2048x1536; fundus photo
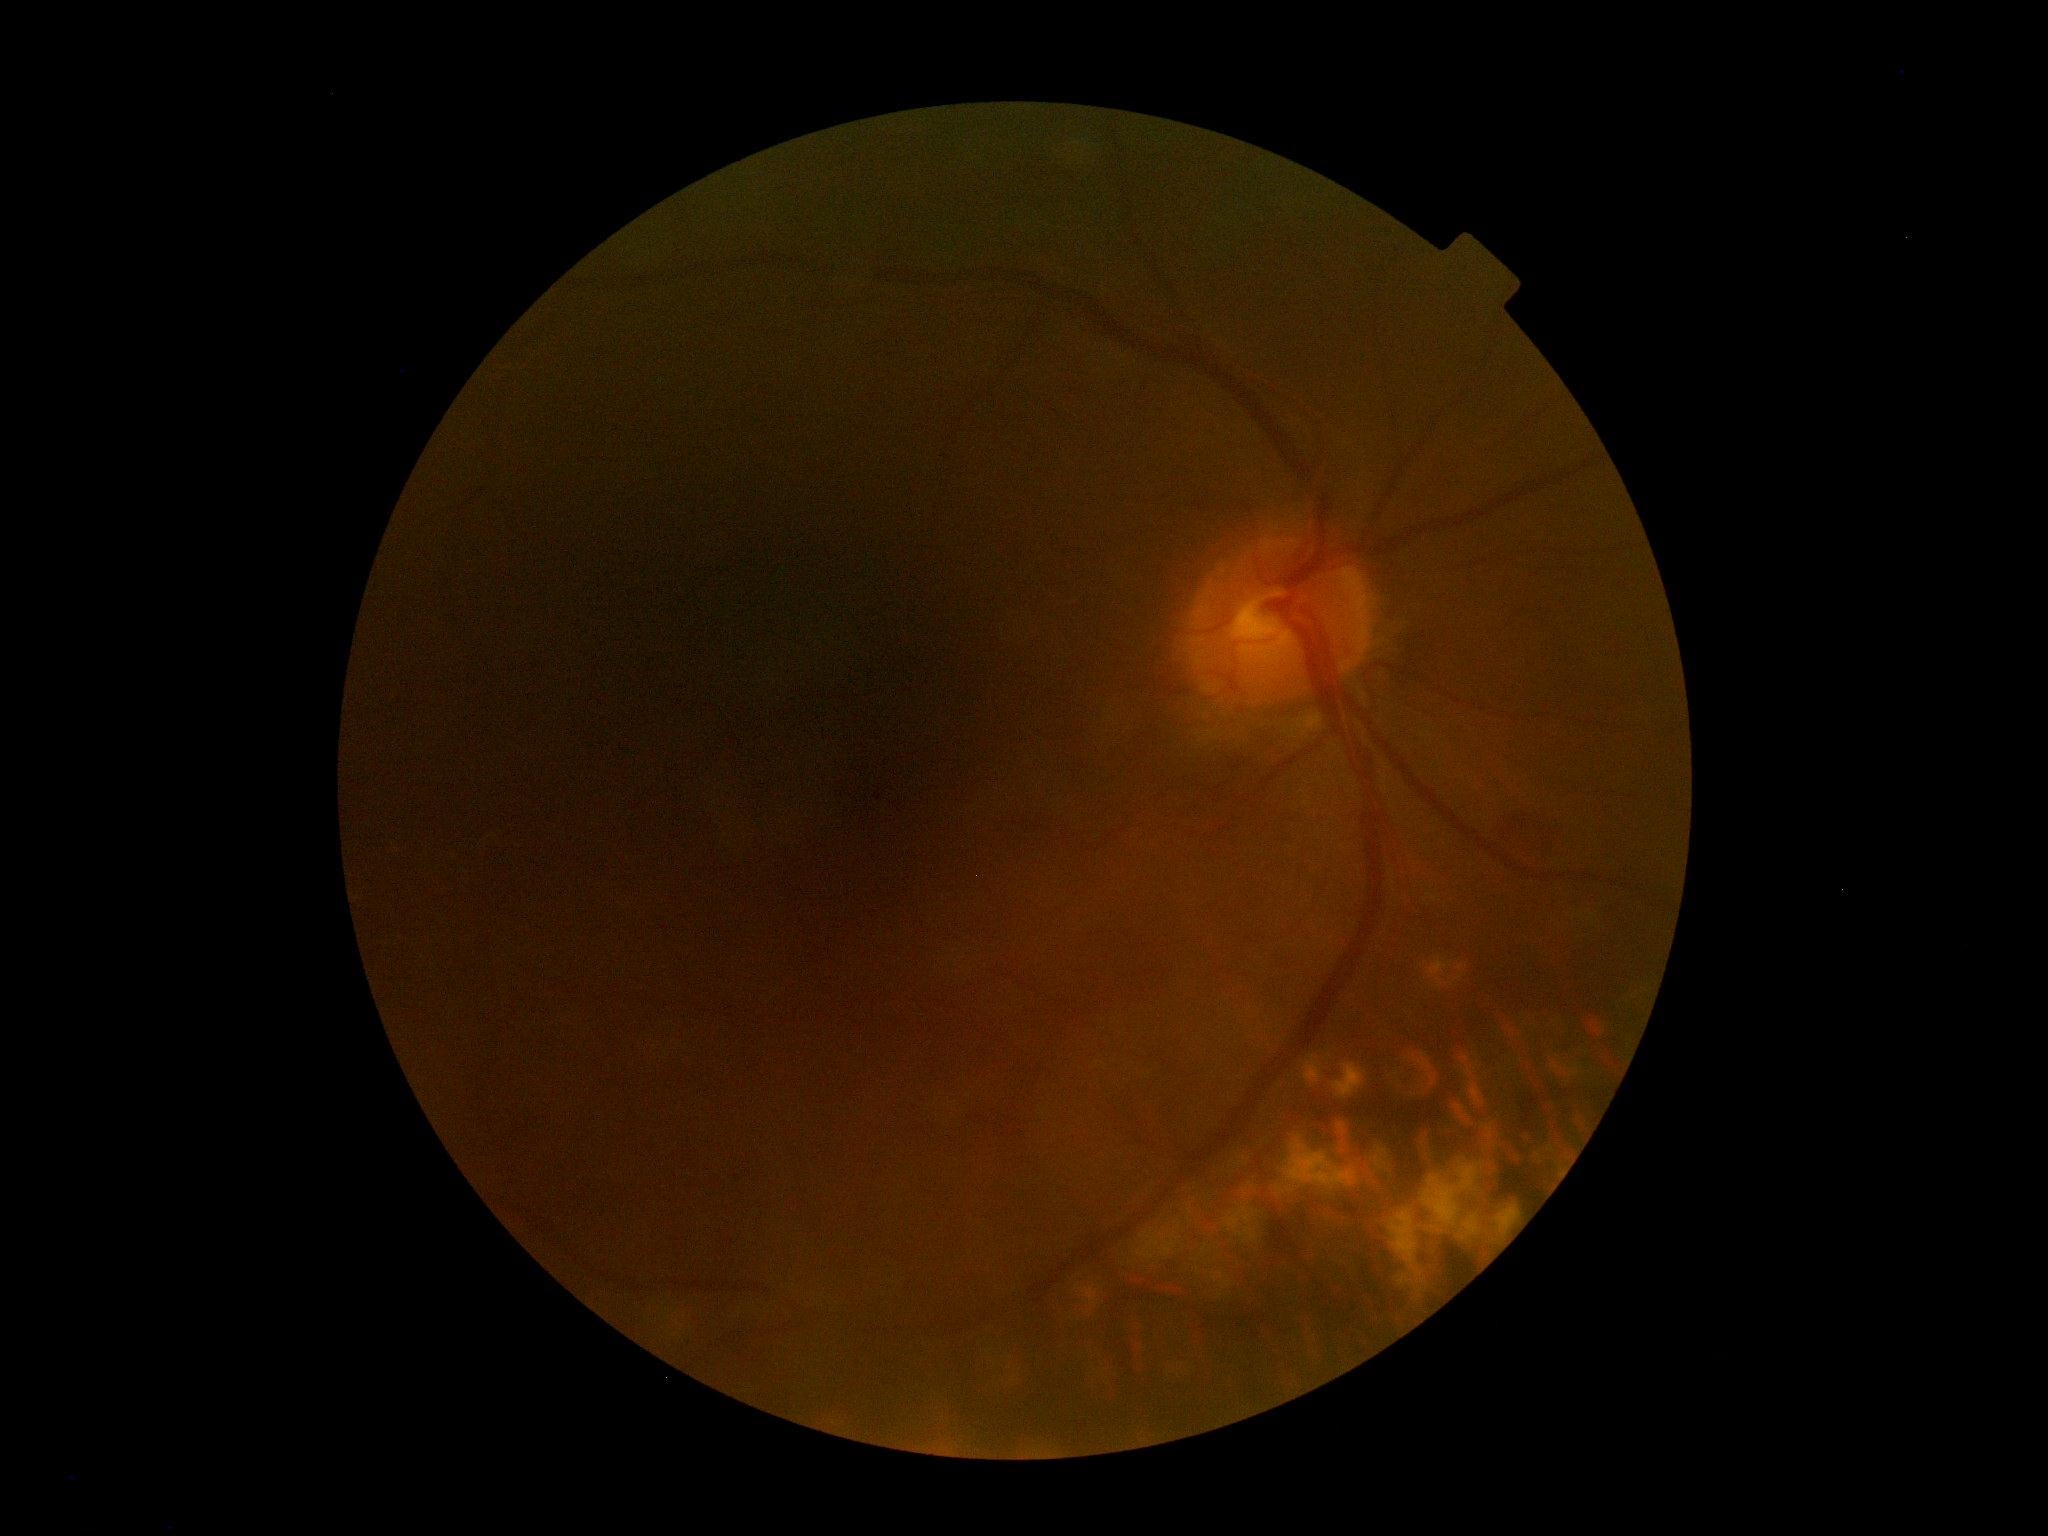
DR grade@2.